45-degree field of view · fundus photo · 2361 by 1568 pixels:
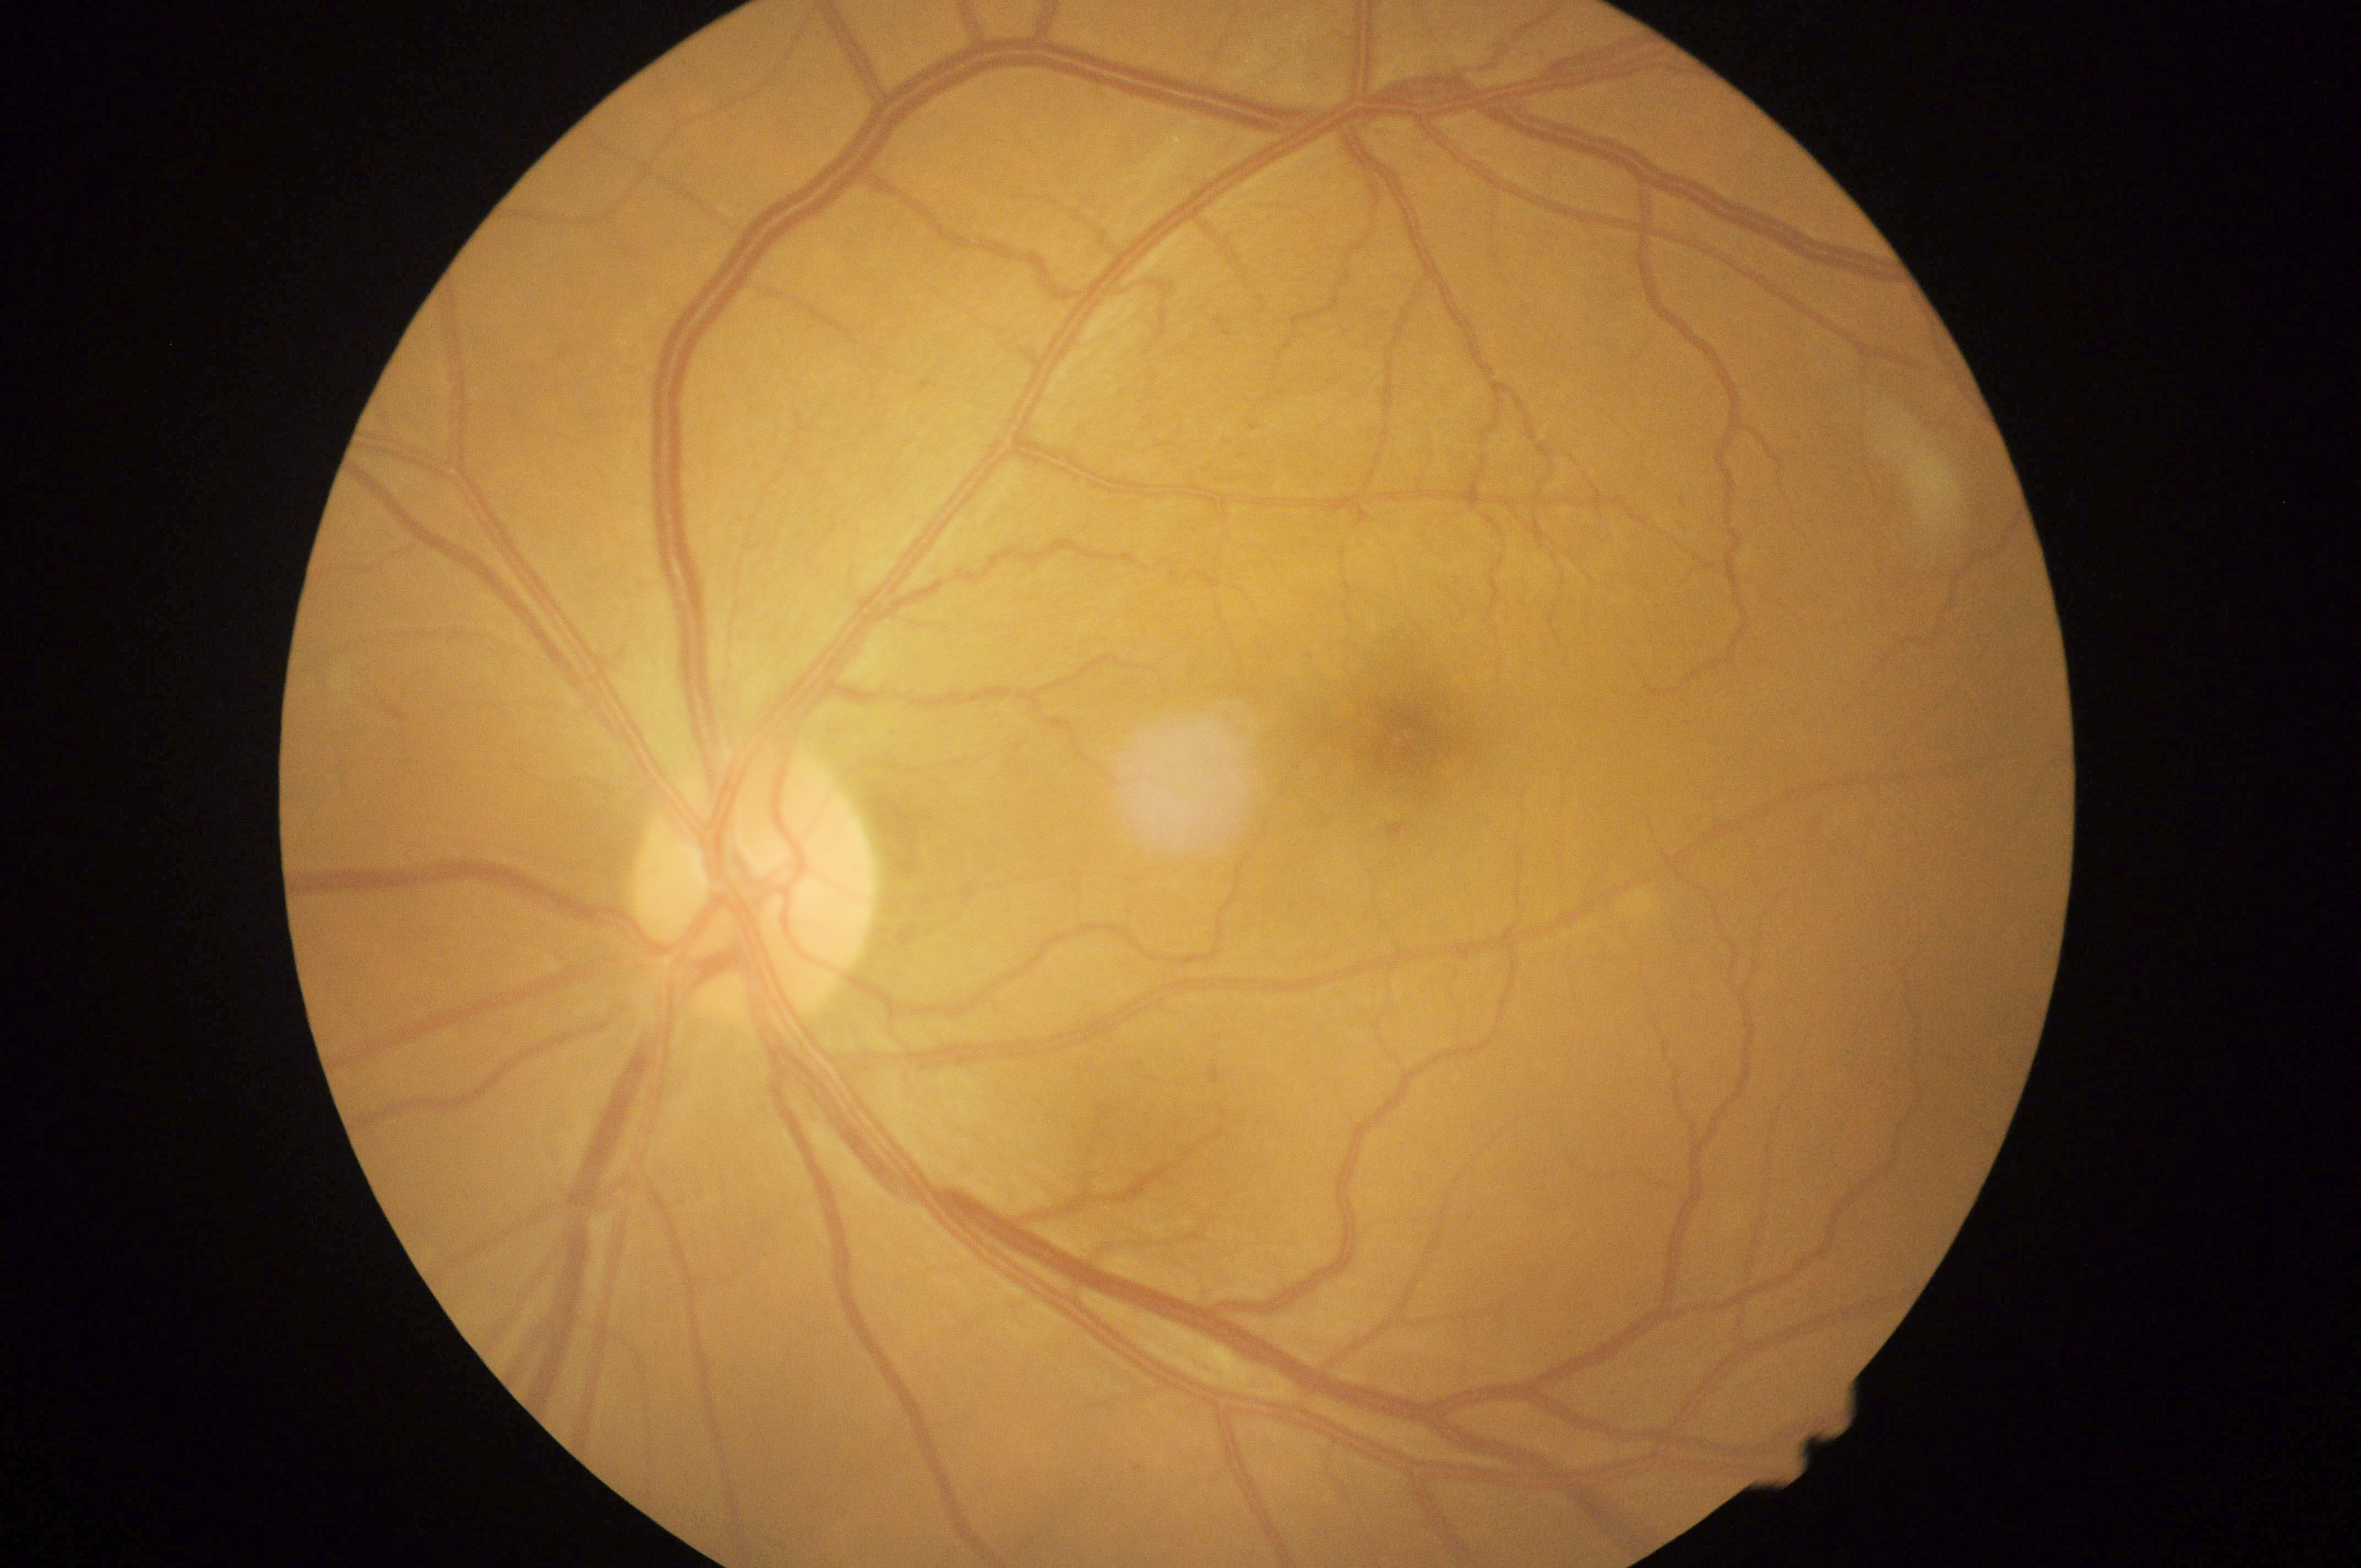
dr_grade: 2/4